640 by 480 pixels · wide-field contact fundus photograph of an infant
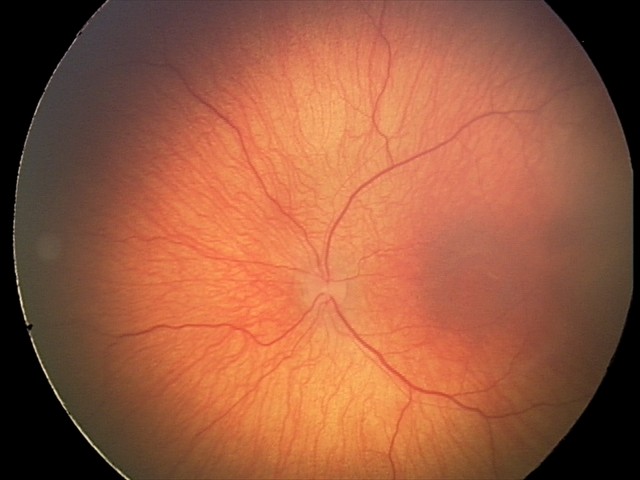 Assessment: status post retinopathy of prematurity — retinal appearance after treated retinopathy of prematurity | no plus disease.